CFP — 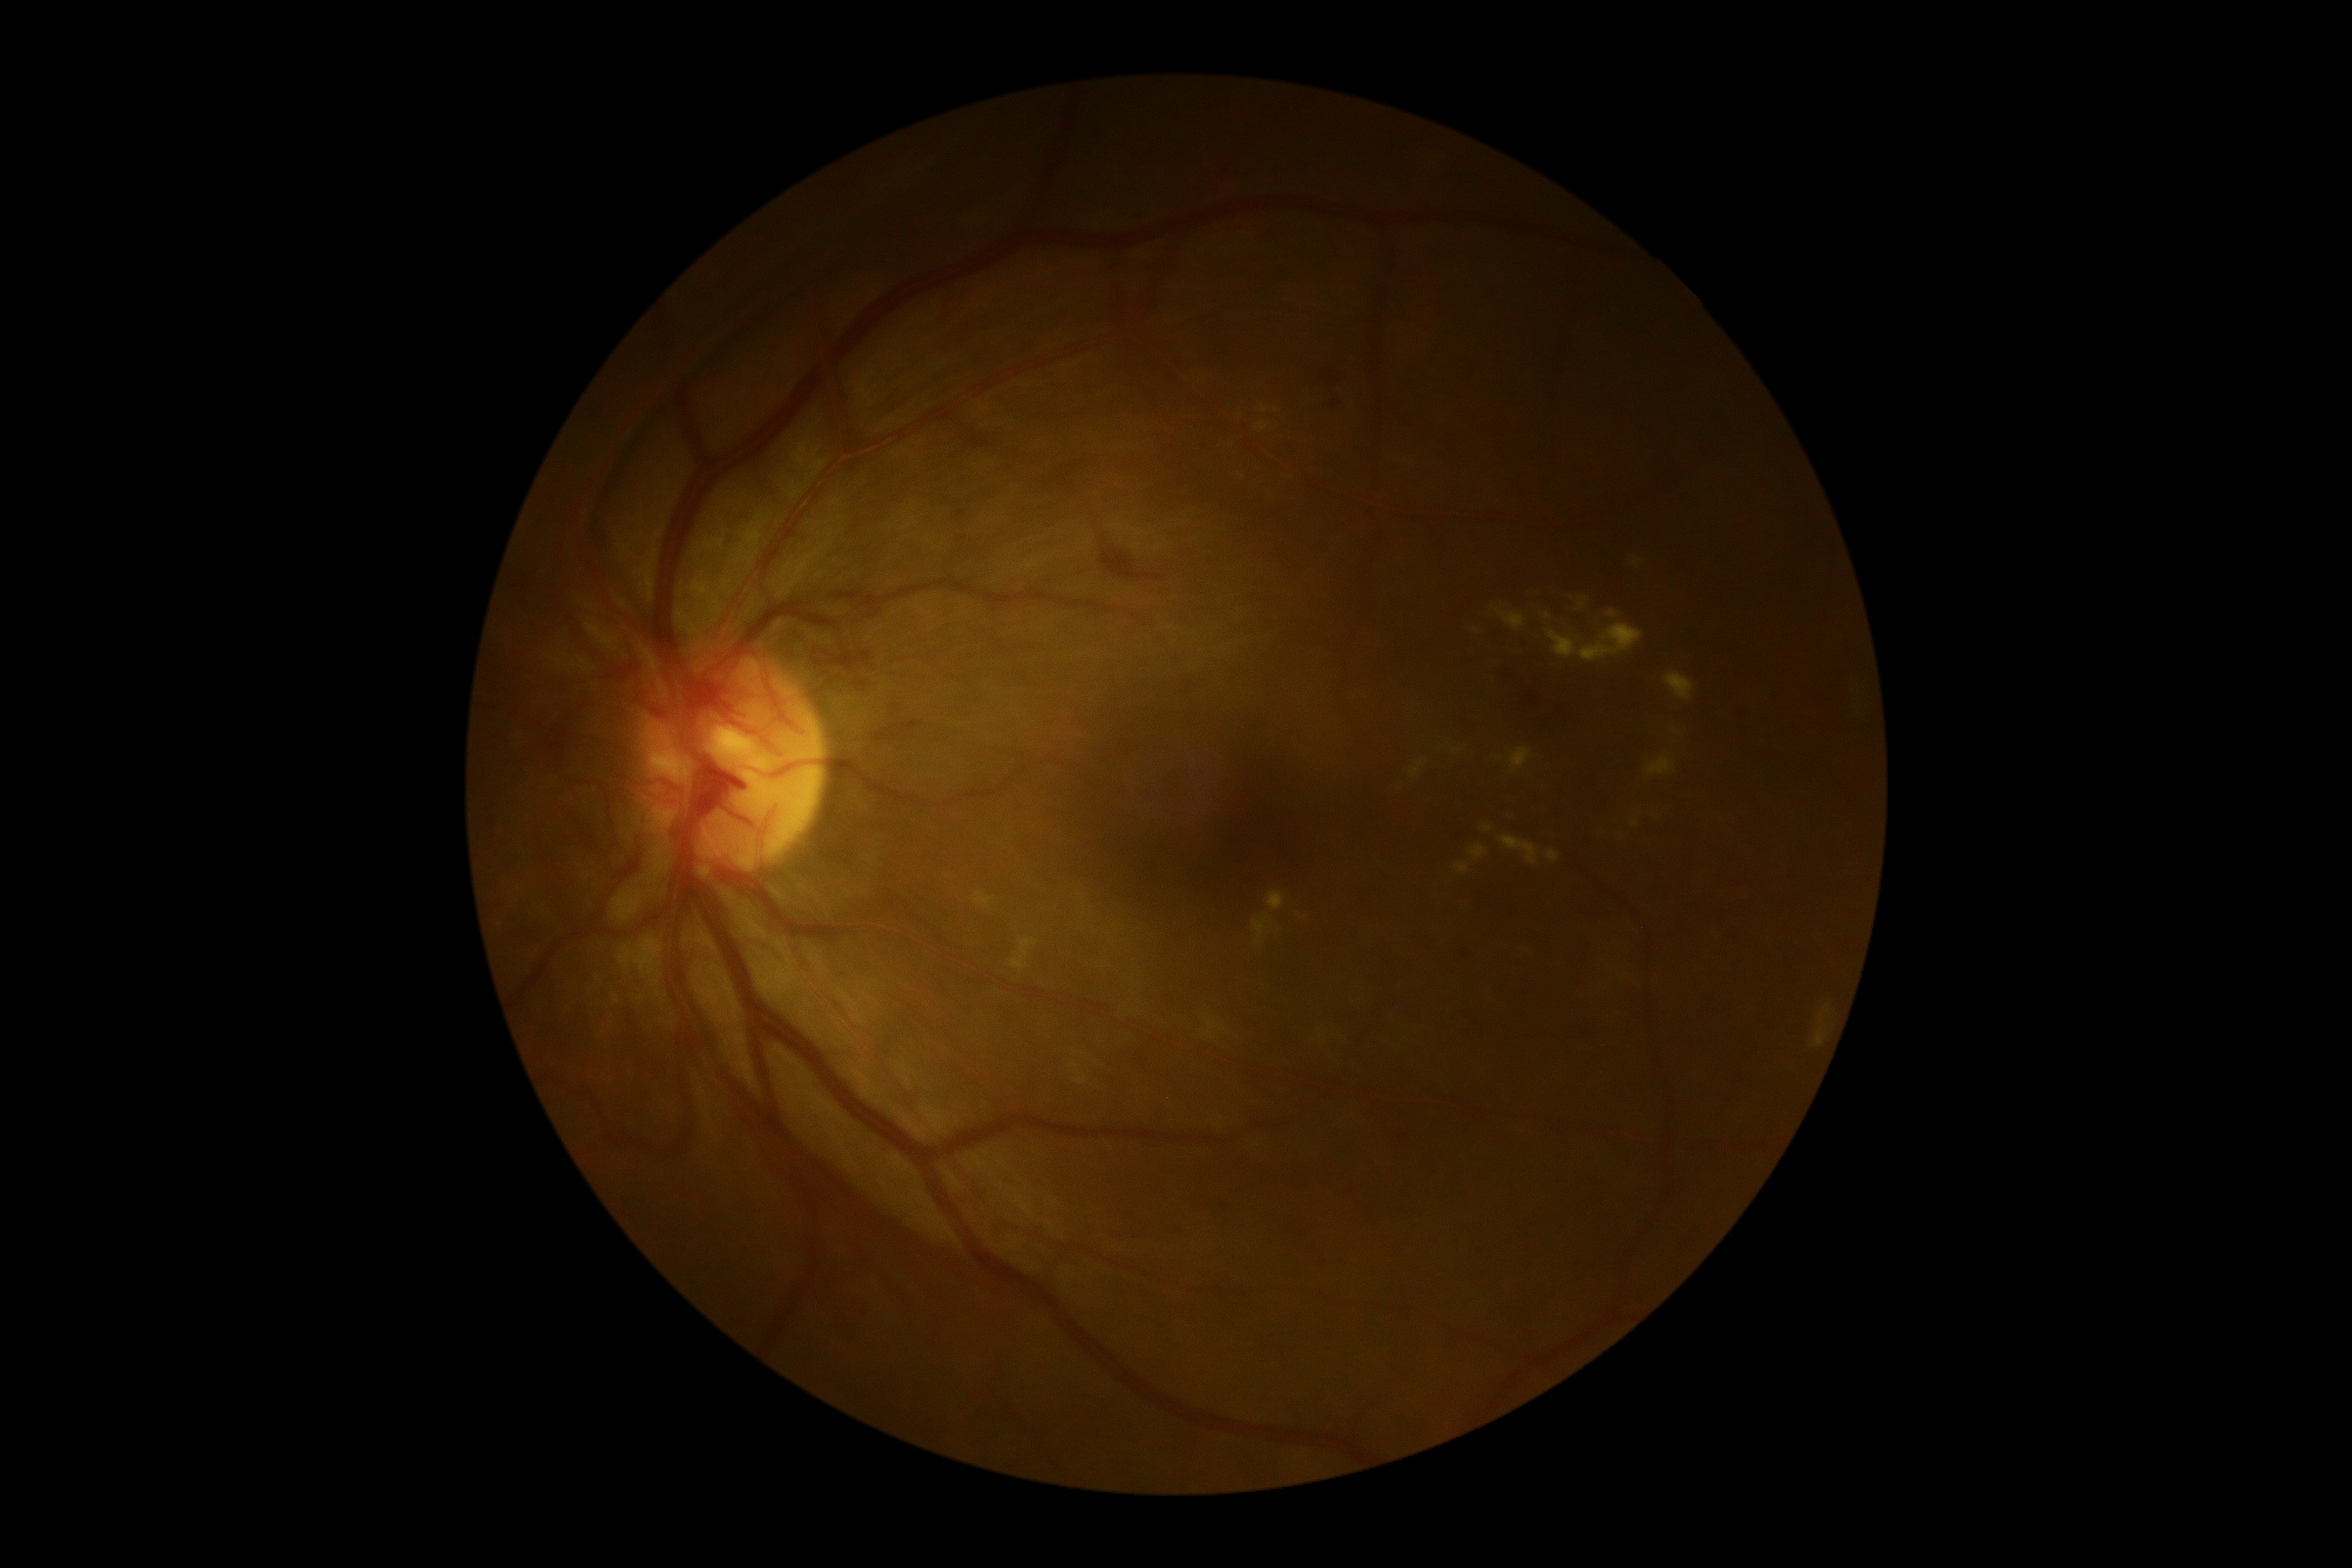

DR grade: 4.